Image size 512x512
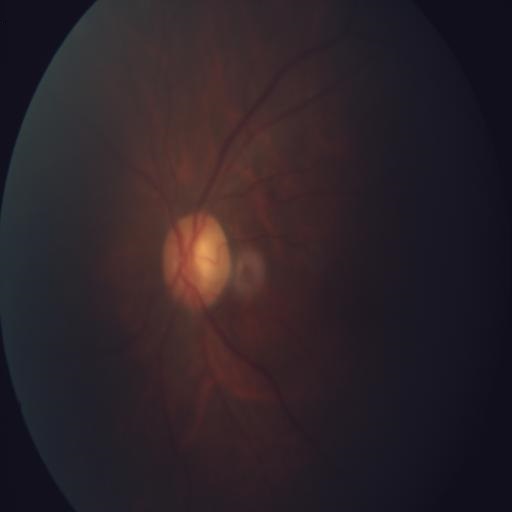
Findings consistent with optic disc pallor (ODP).